Pupil-dilated: 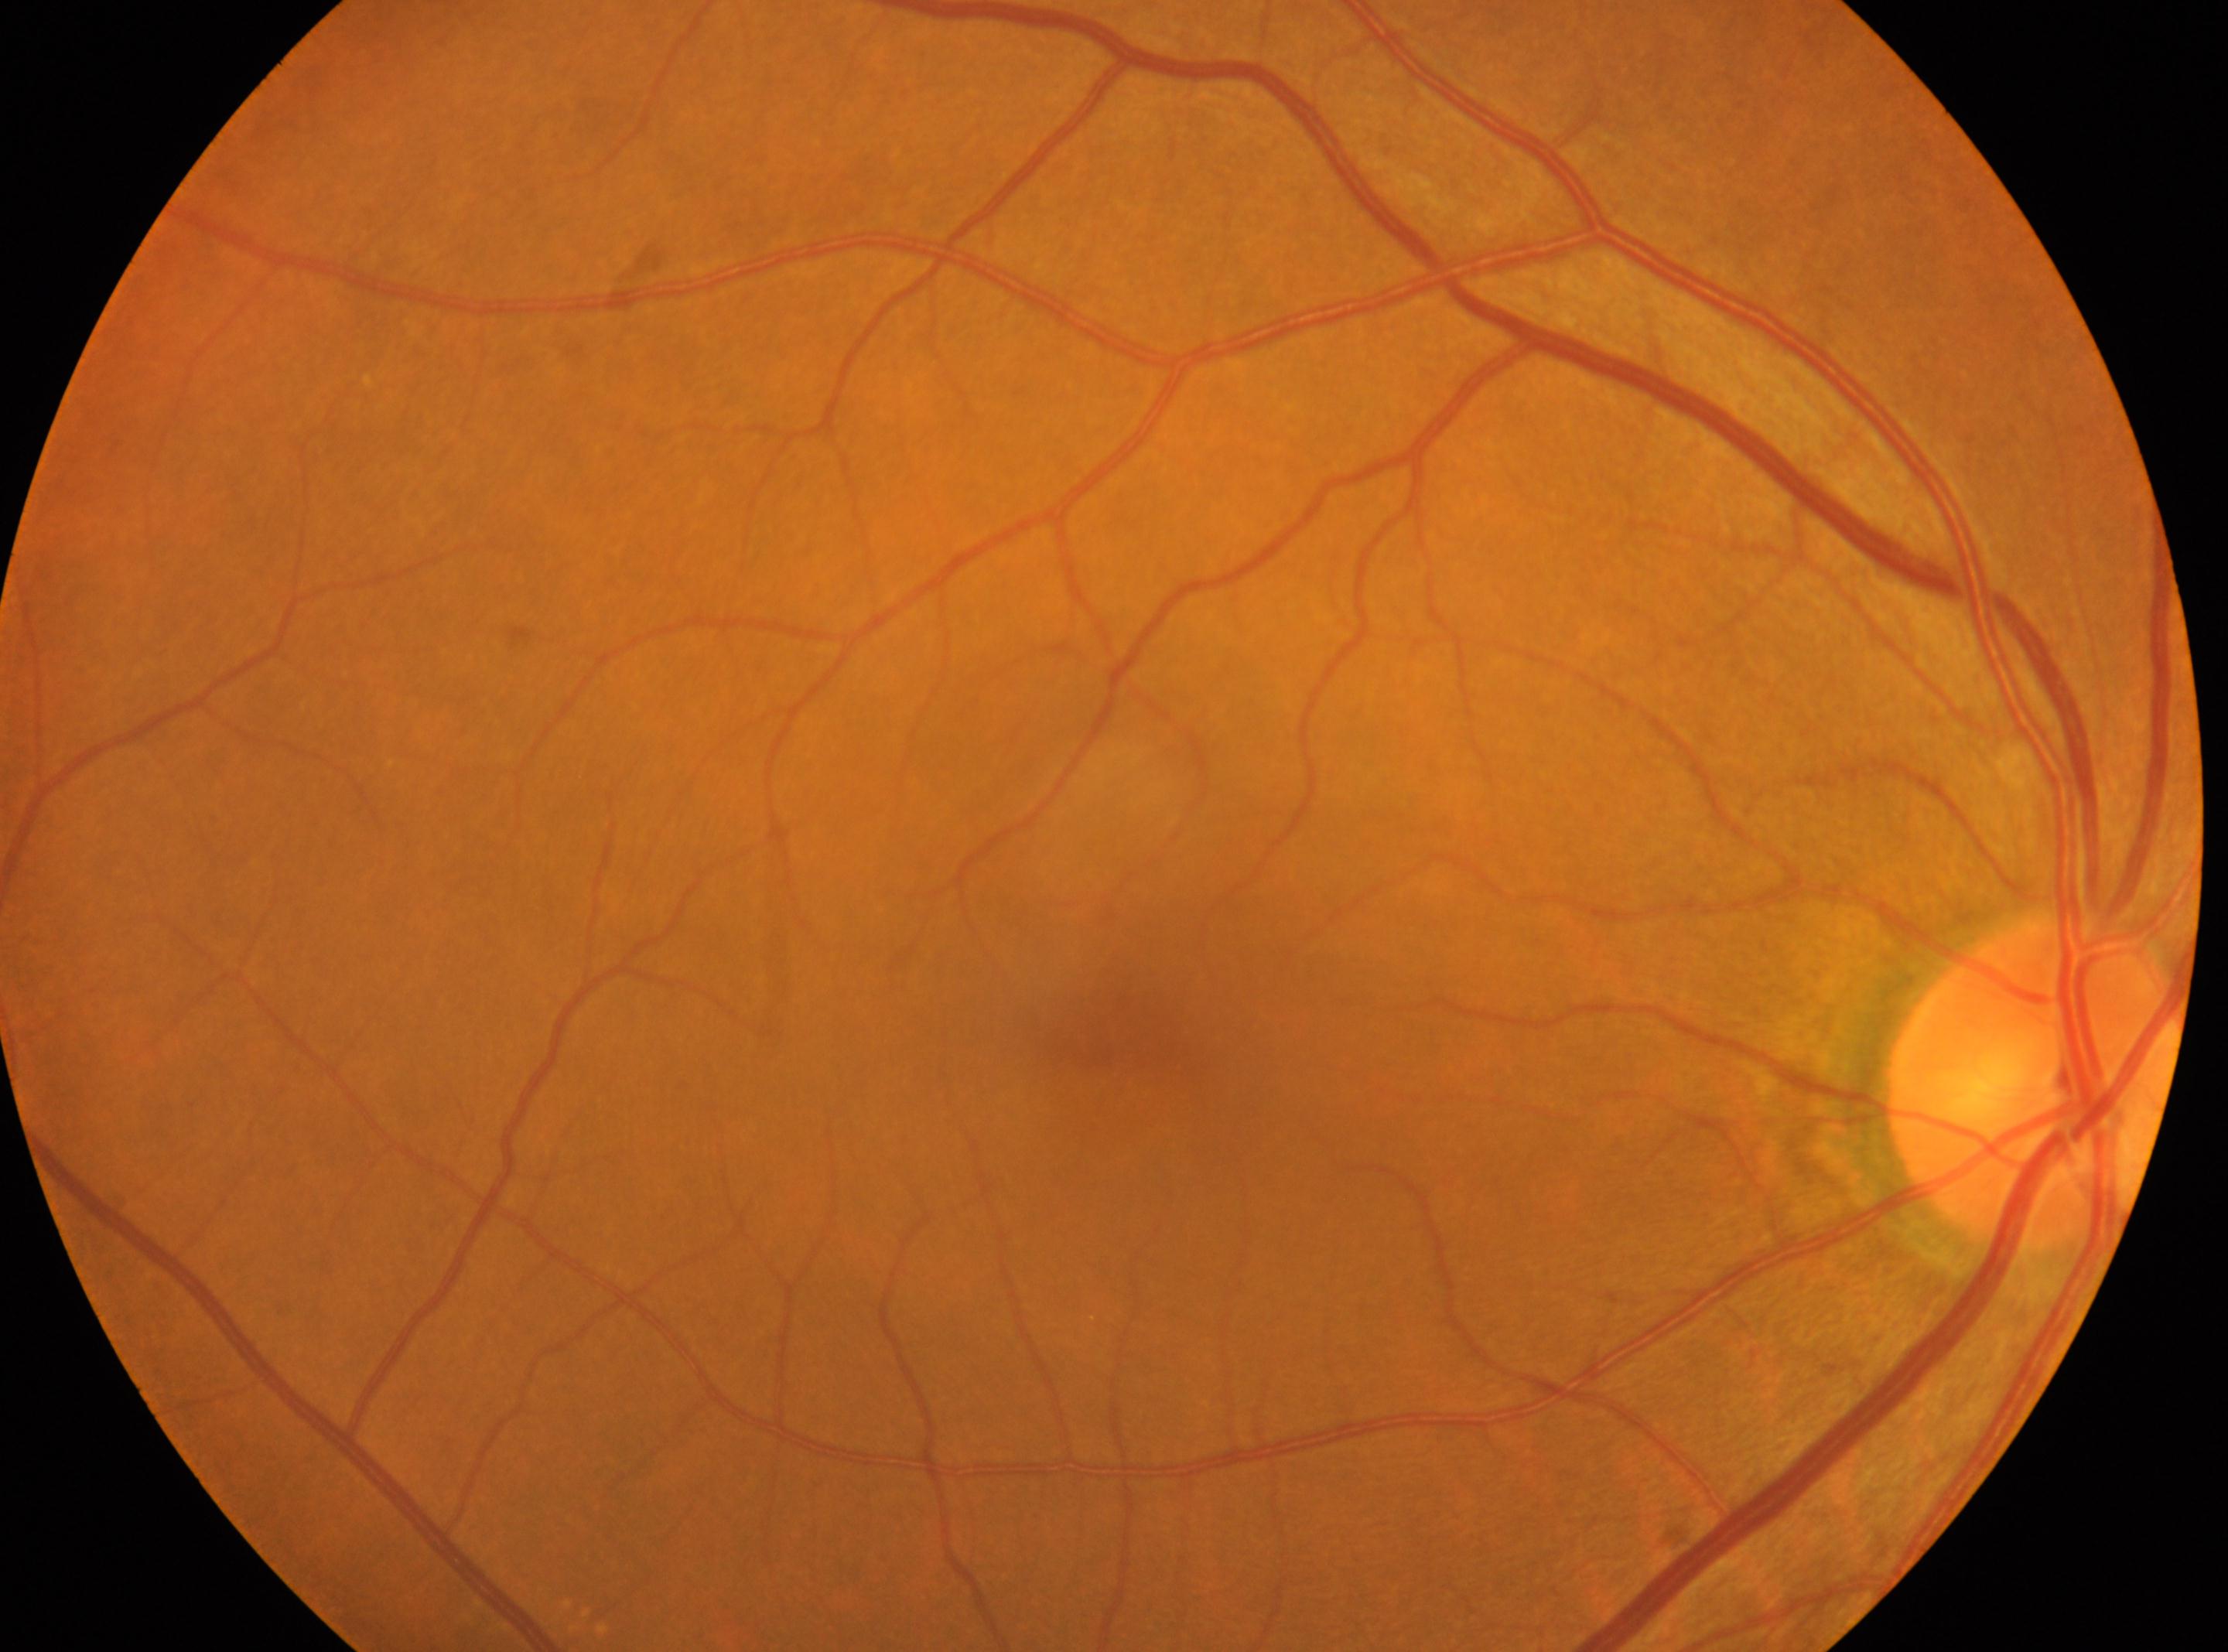

No diabetic retinopathy identified.
Optic nerve head: (2034, 1078).
The fovea centralis is at (1120, 1024).
DR: 0.
This is the right eye.